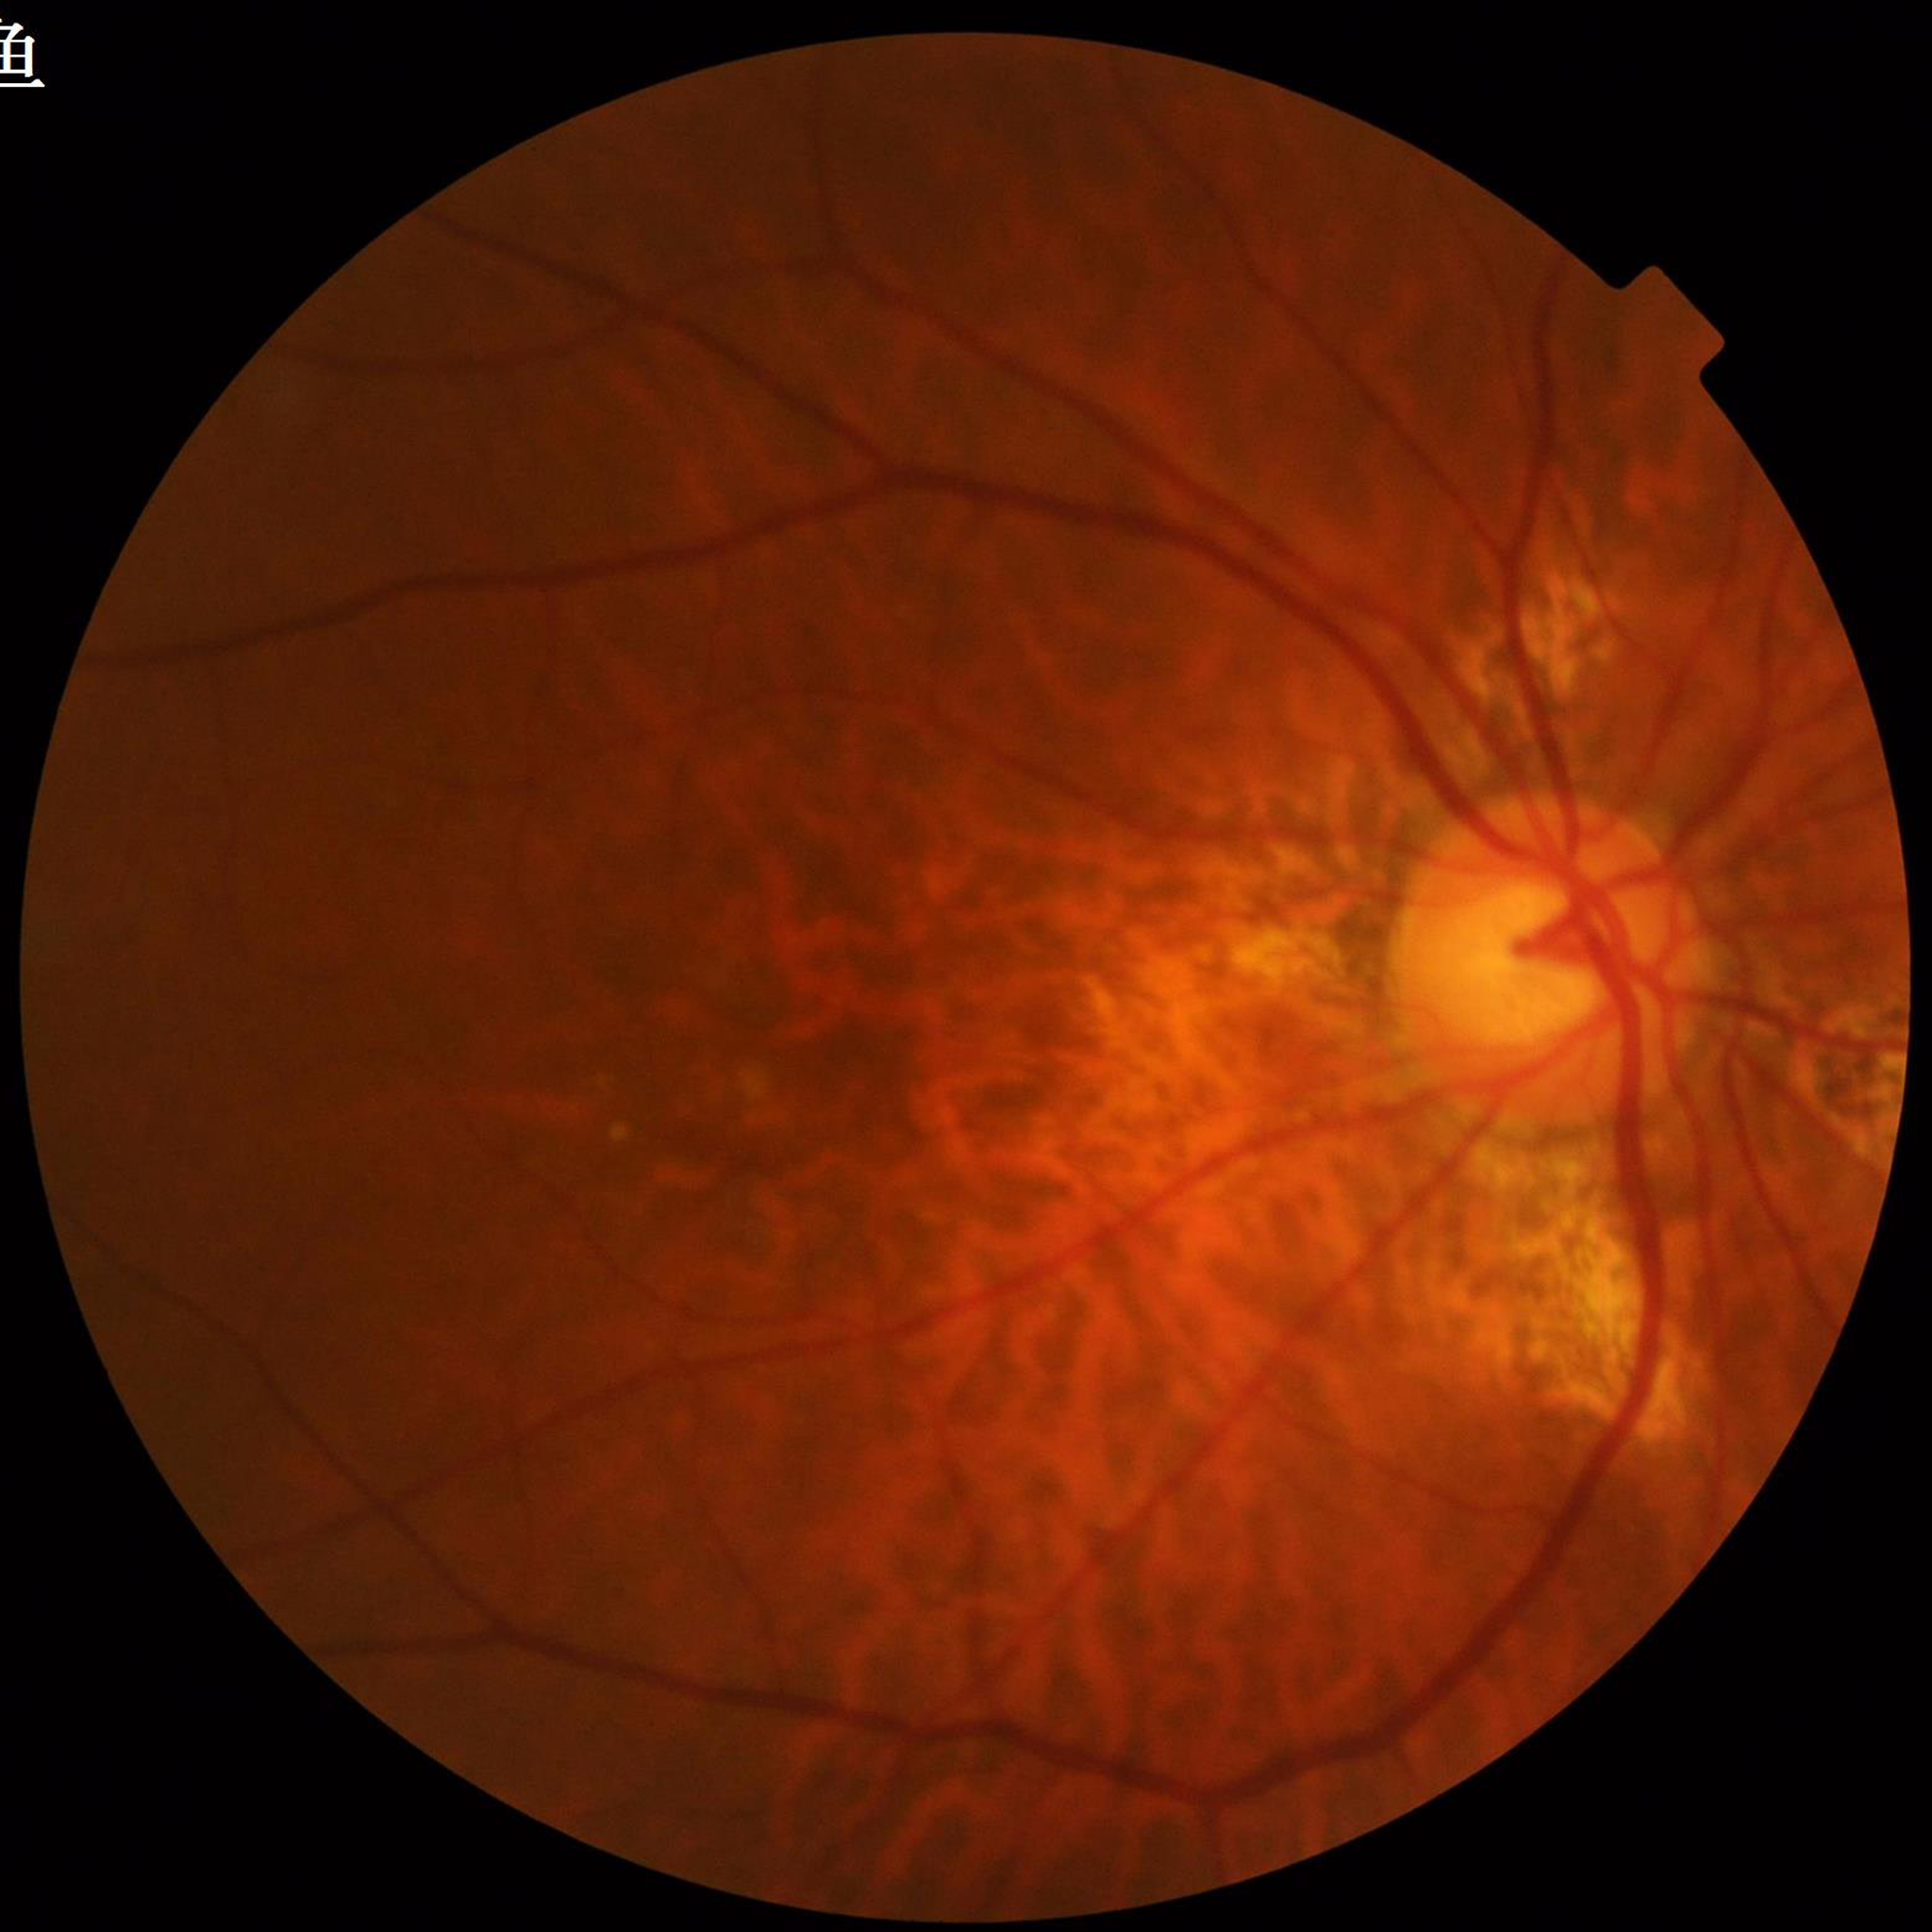 Color fundus photo. Patient diagnosed with AMD.